Without pupil dilation, 848x848px: 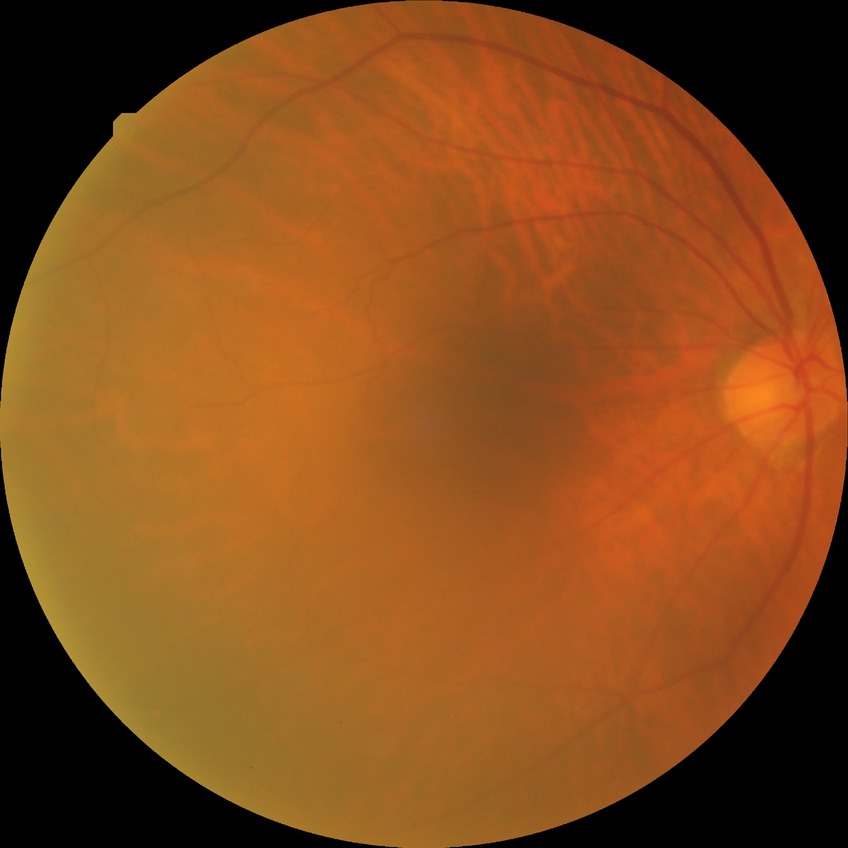 {"davis_grade": "no diabetic retinopathy (NDR)"}